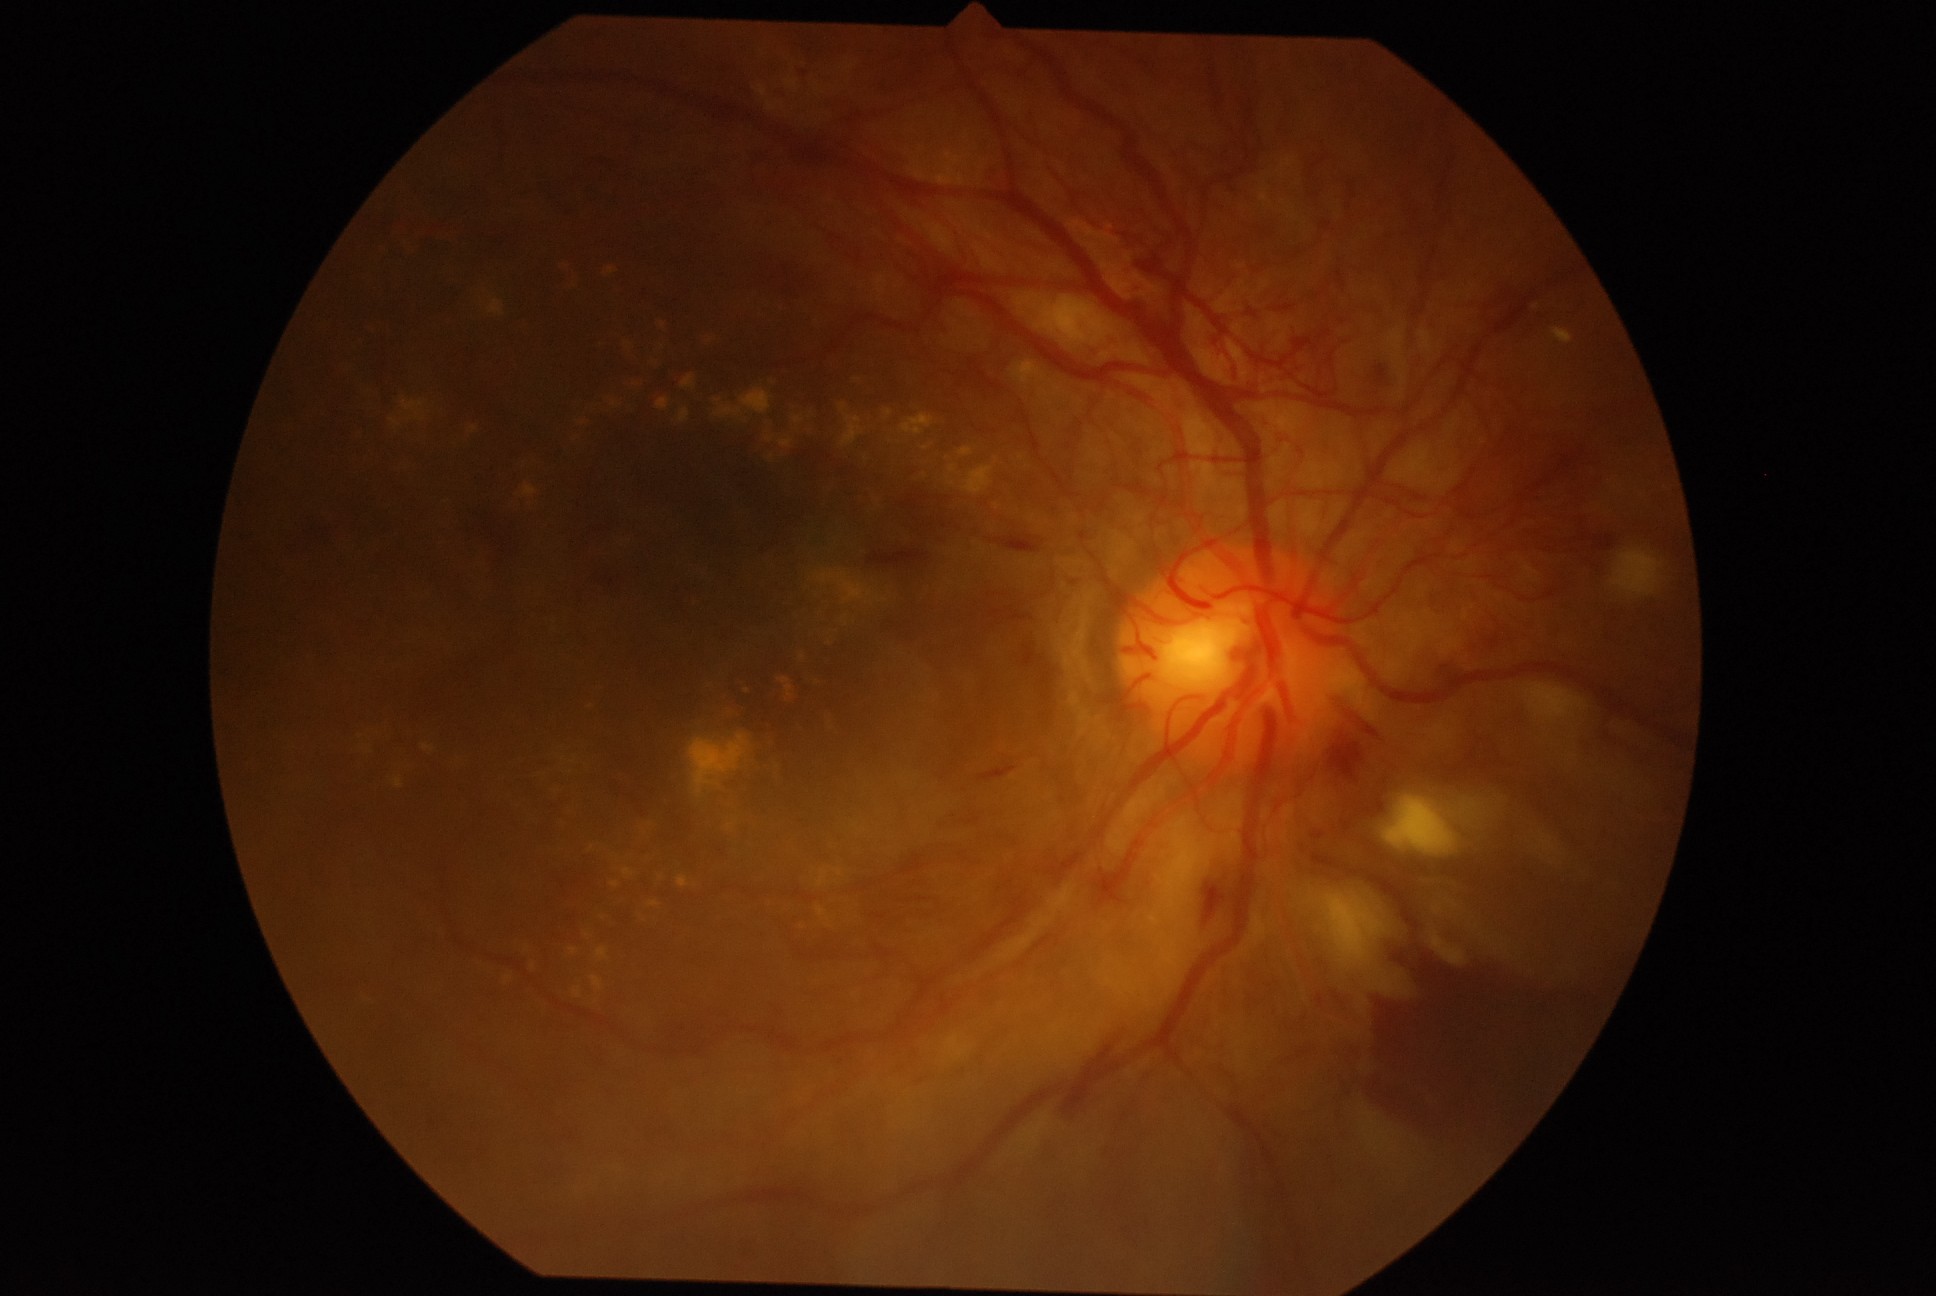 • DR stage — grade 4 (PDR)